Color fundus image: 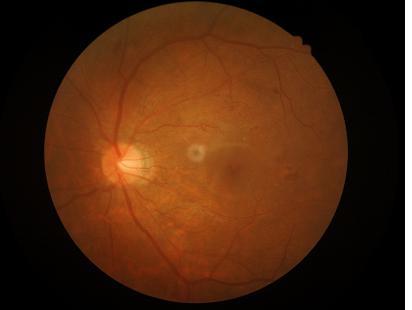 Contrast: satisfactory; Sharpness: good; Overall quality: satisfactory.